Field includes the optic disc and macula. 50-degree field of view. 2228 x 1652 pixels: 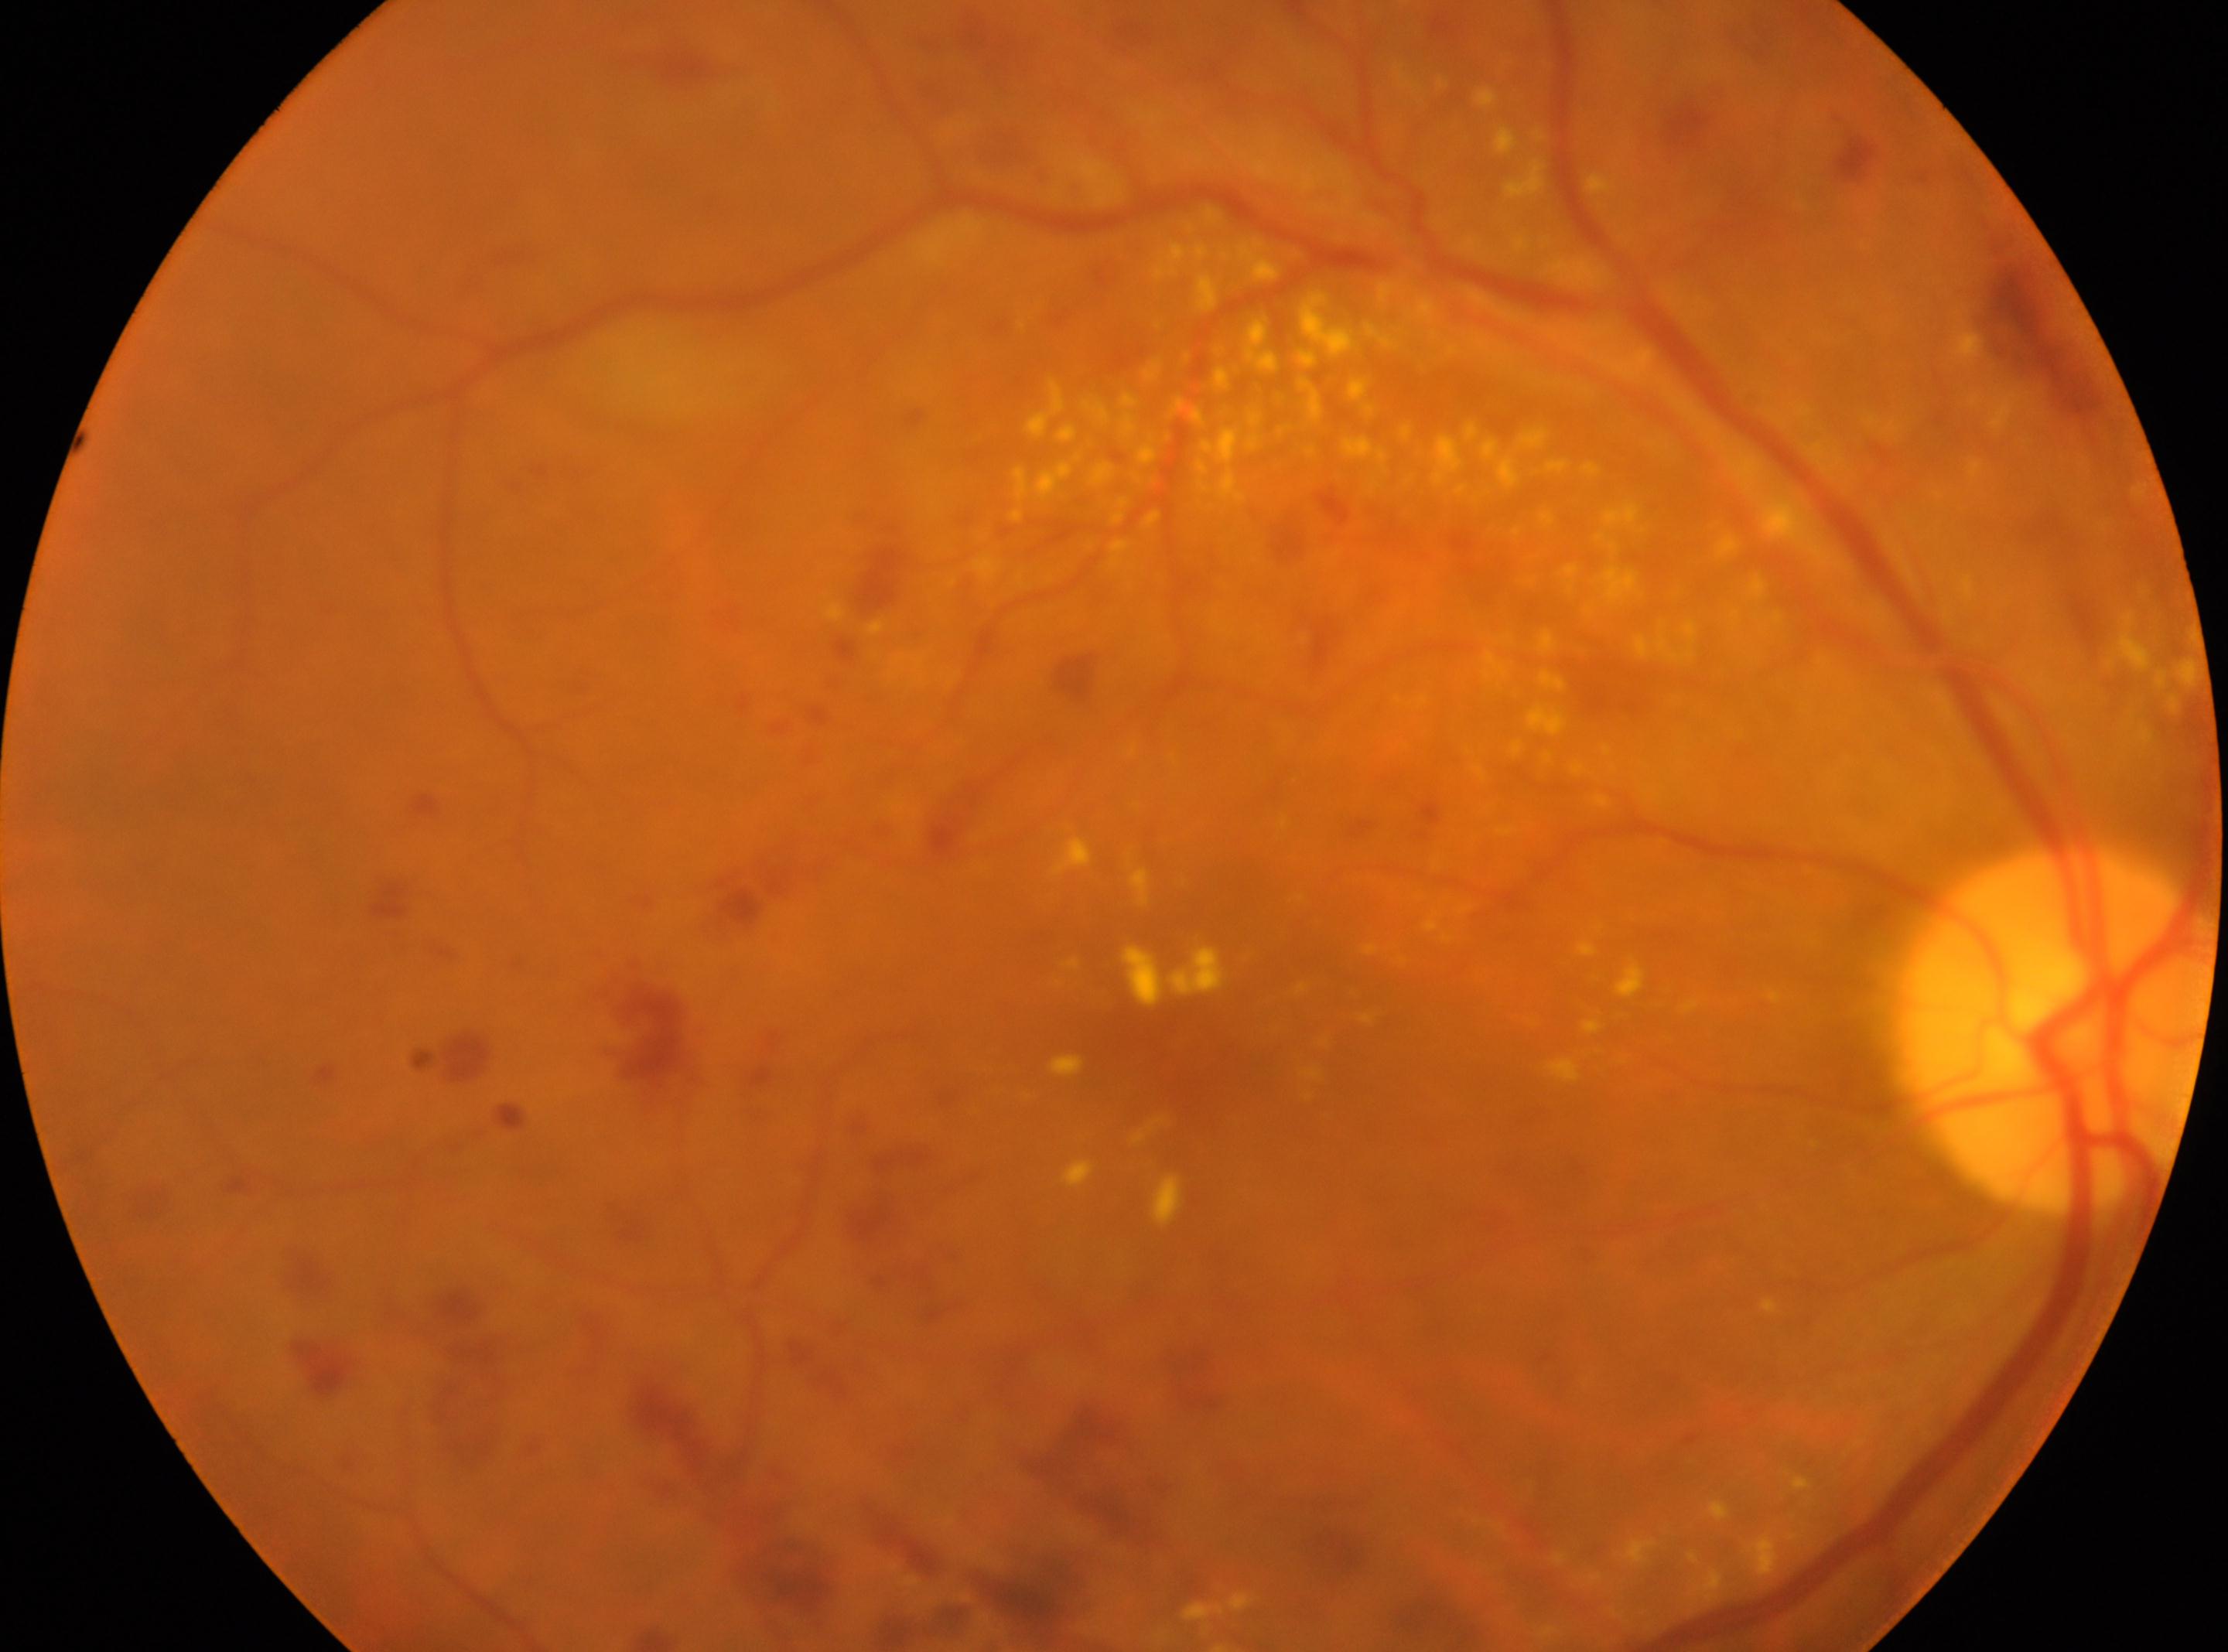
Findings:
• macula center: 1174px, 1056px
• laterality: the right eye
• ONH: 2054px, 1026px
• DR class: non-proliferative diabetic retinopathy
• DR severity: grade 2 (moderate NPDR)